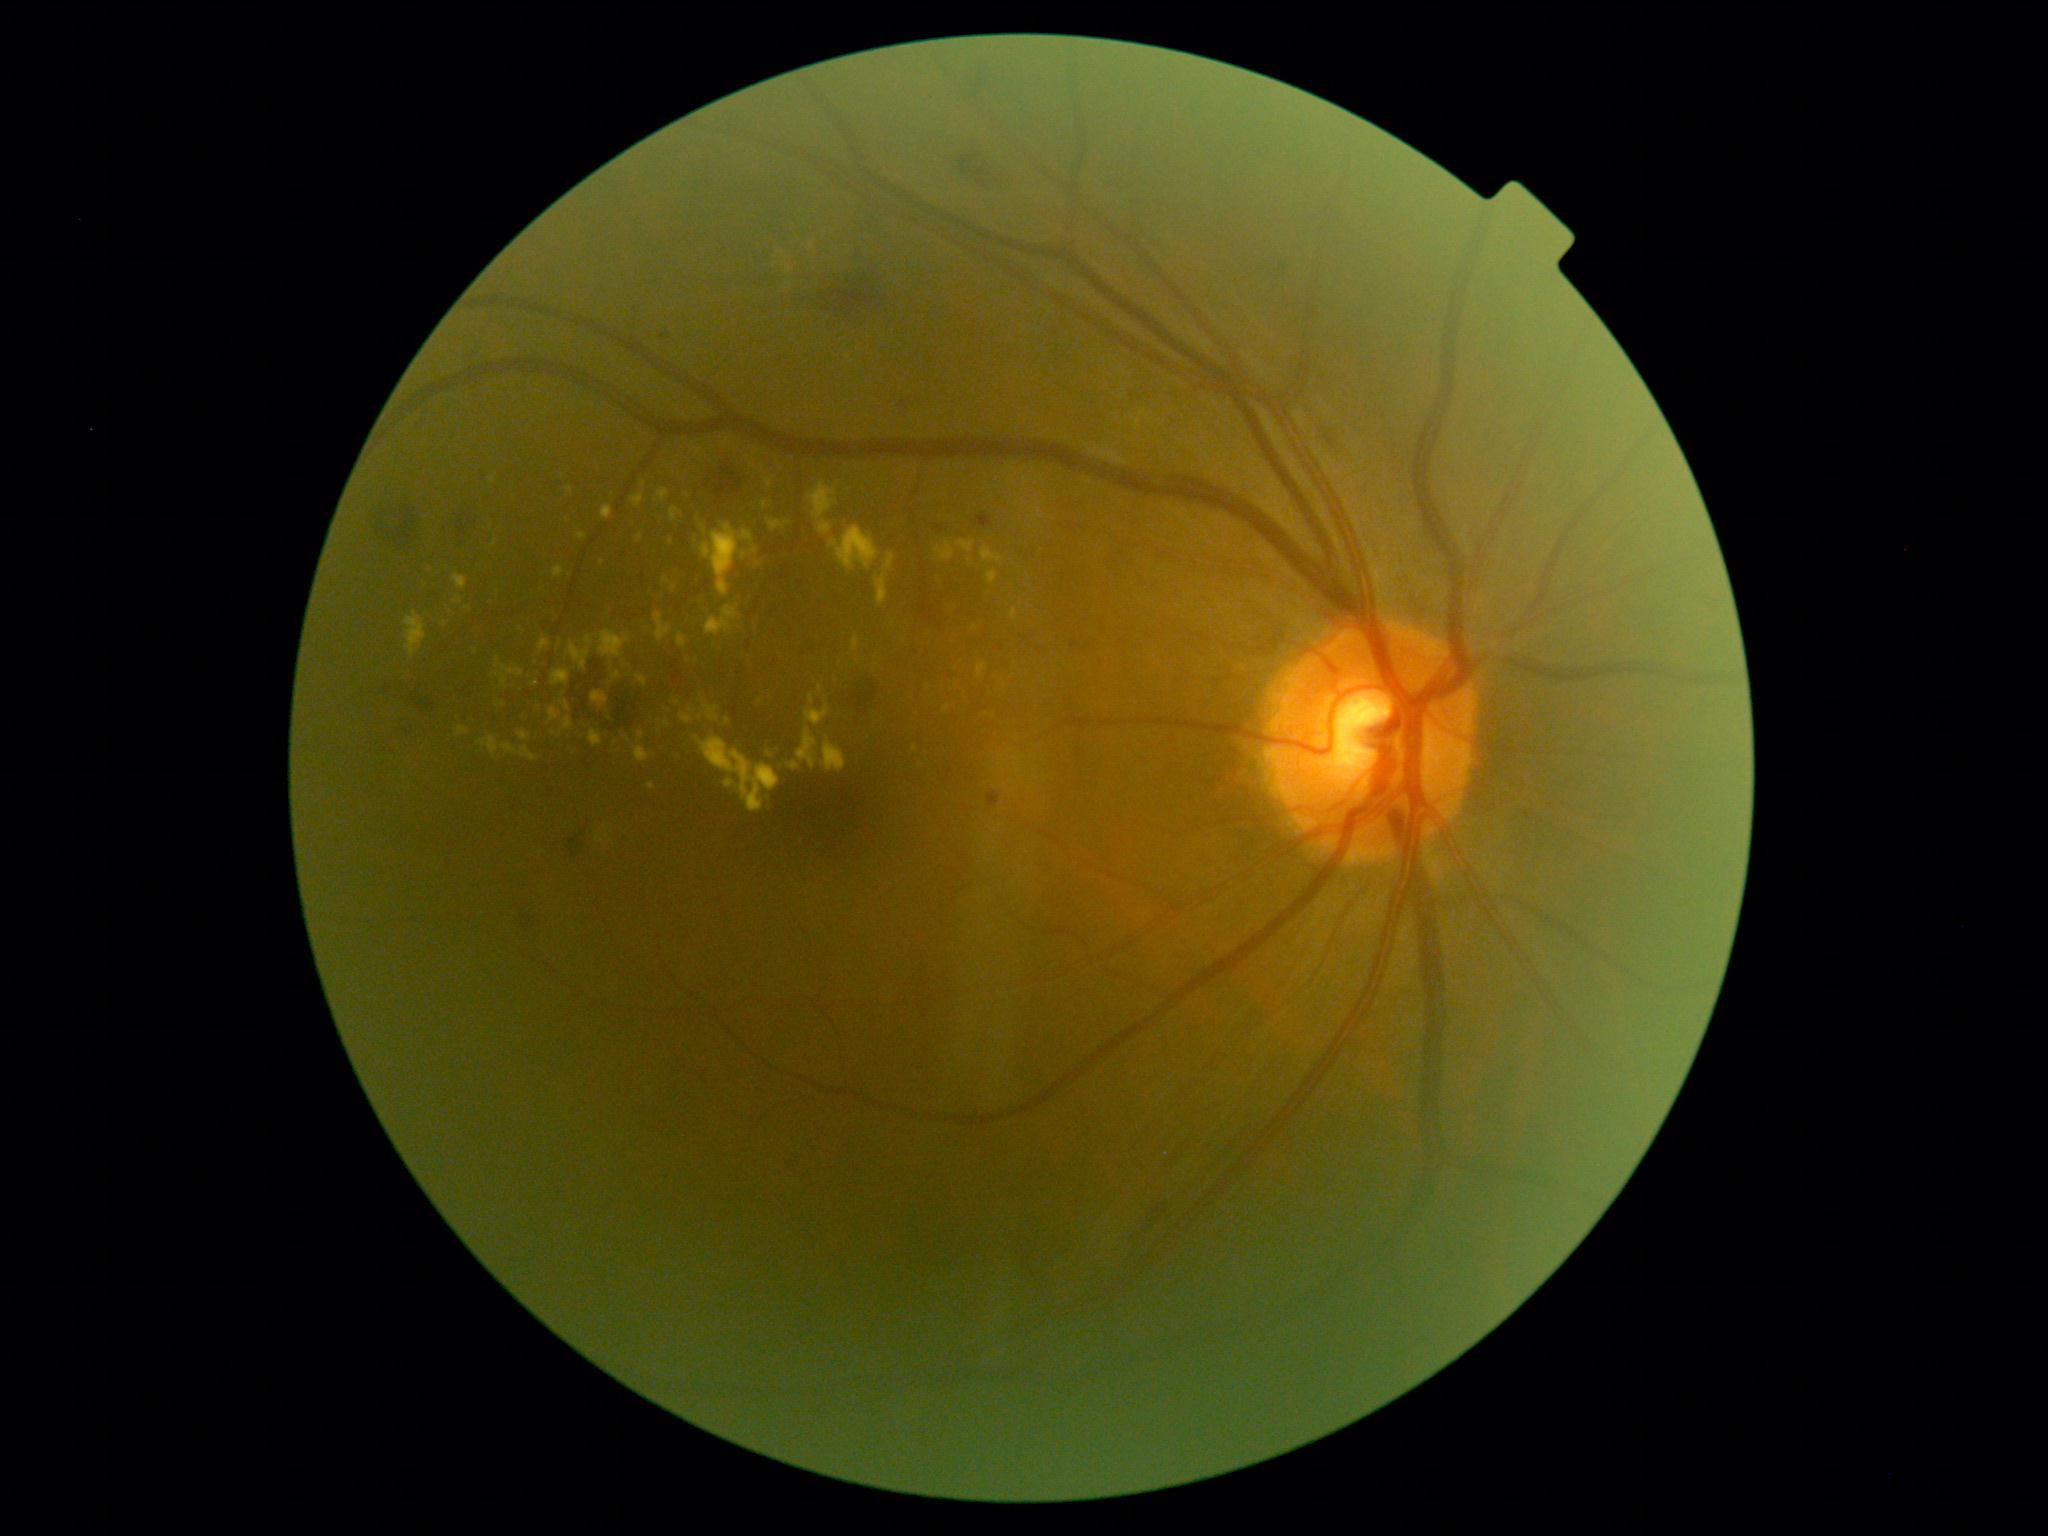

DR severity: 2. HEs located at [849,680,879,716] | [374,502,418,548] | [460,509,473,528] | [715,466,745,499] | [1137,1205,1167,1235] | [574,661,643,726] | [958,151,991,181] | [814,251,884,323] | [567,836,580,859] | [411,697,435,711] | [523,916,531,928]. No SEs identified. MAs located at [1071,641,1079,648] | [996,645,1003,653] | [979,515,989,524] | [988,792,1001,808]. Small MAs approximately at x=485, y=478 | x=665, y=336. EXs (partial list) at [696,737,781,813] | [1013,756,1026,775] | [678,634,688,648] | [676,750,681,761] | [632,493,645,508] | [405,611,427,658] | [767,519,790,534] | [523,710,530,723] | [501,743,539,762] | [553,565,564,579] | [765,479,772,488]. Small EXs approximately at x=1011, y=751 | x=667, y=724 | x=691, y=711 | x=700, y=718 | x=1010, y=781 | x=570, y=489 | x=728, y=721.